2352 x 1568 pixels; FOV: 45 degrees; color fundus photograph: 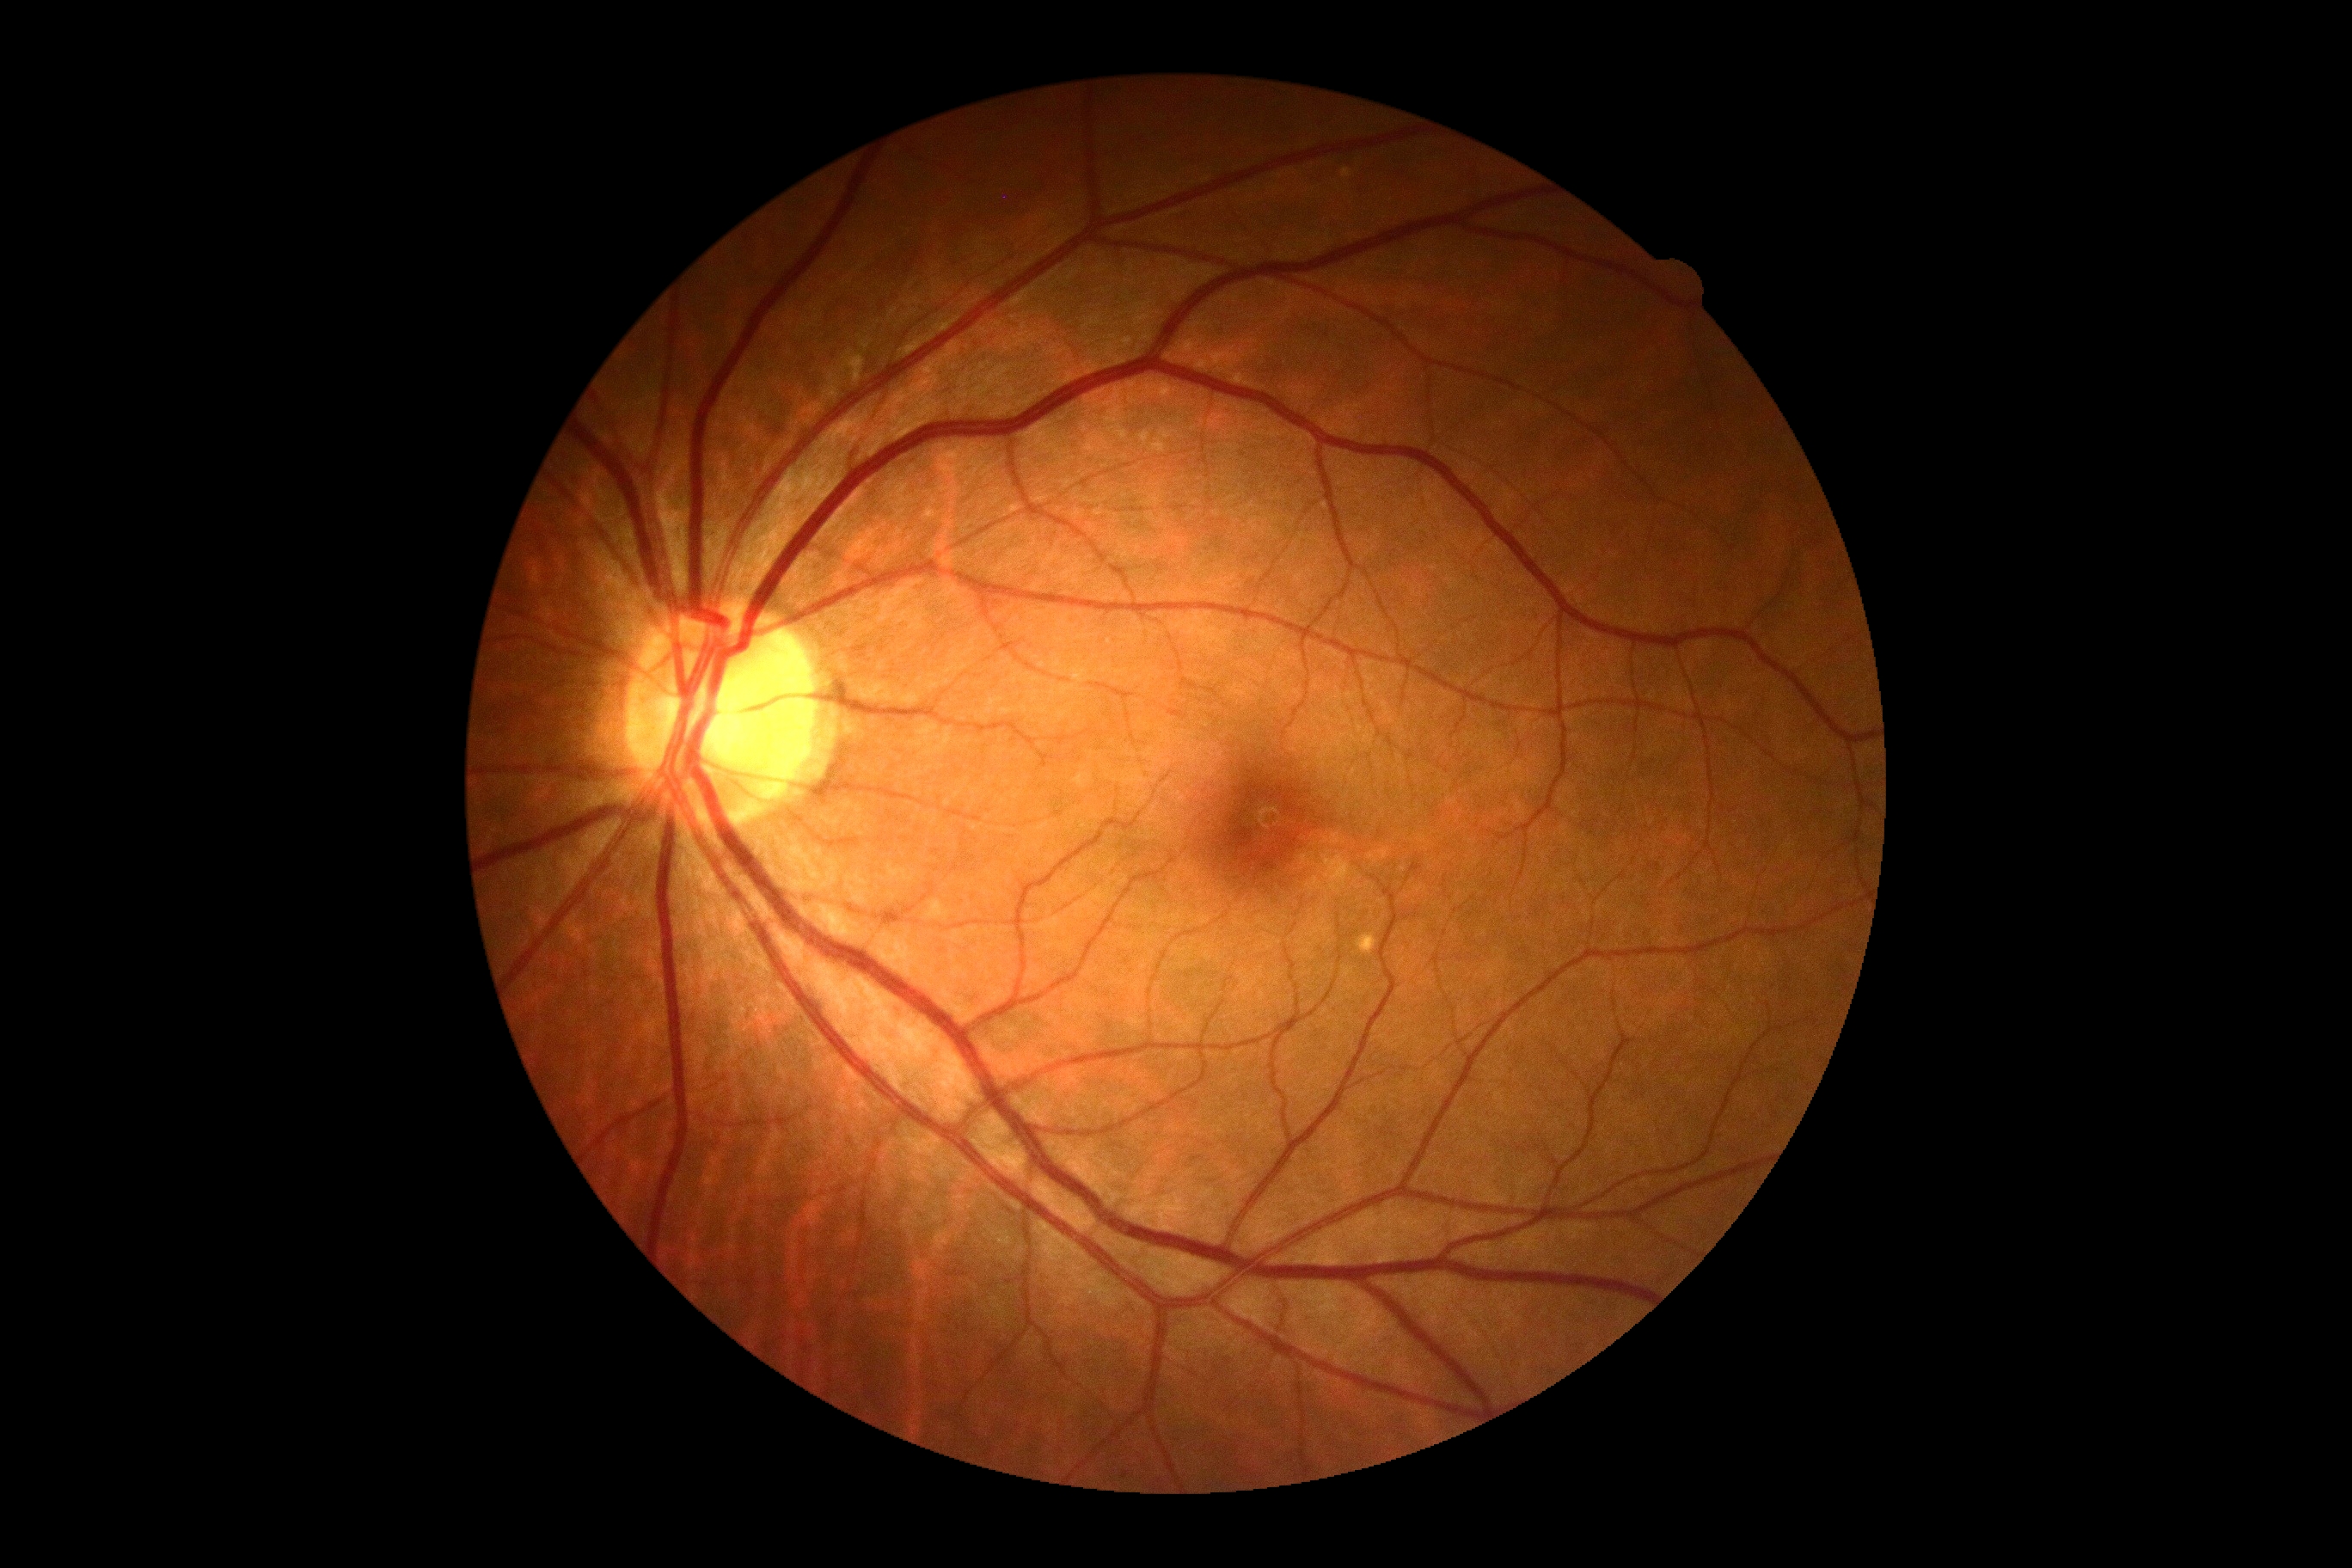

DR severity=no apparent retinopathy (grade 0).